45° field of view
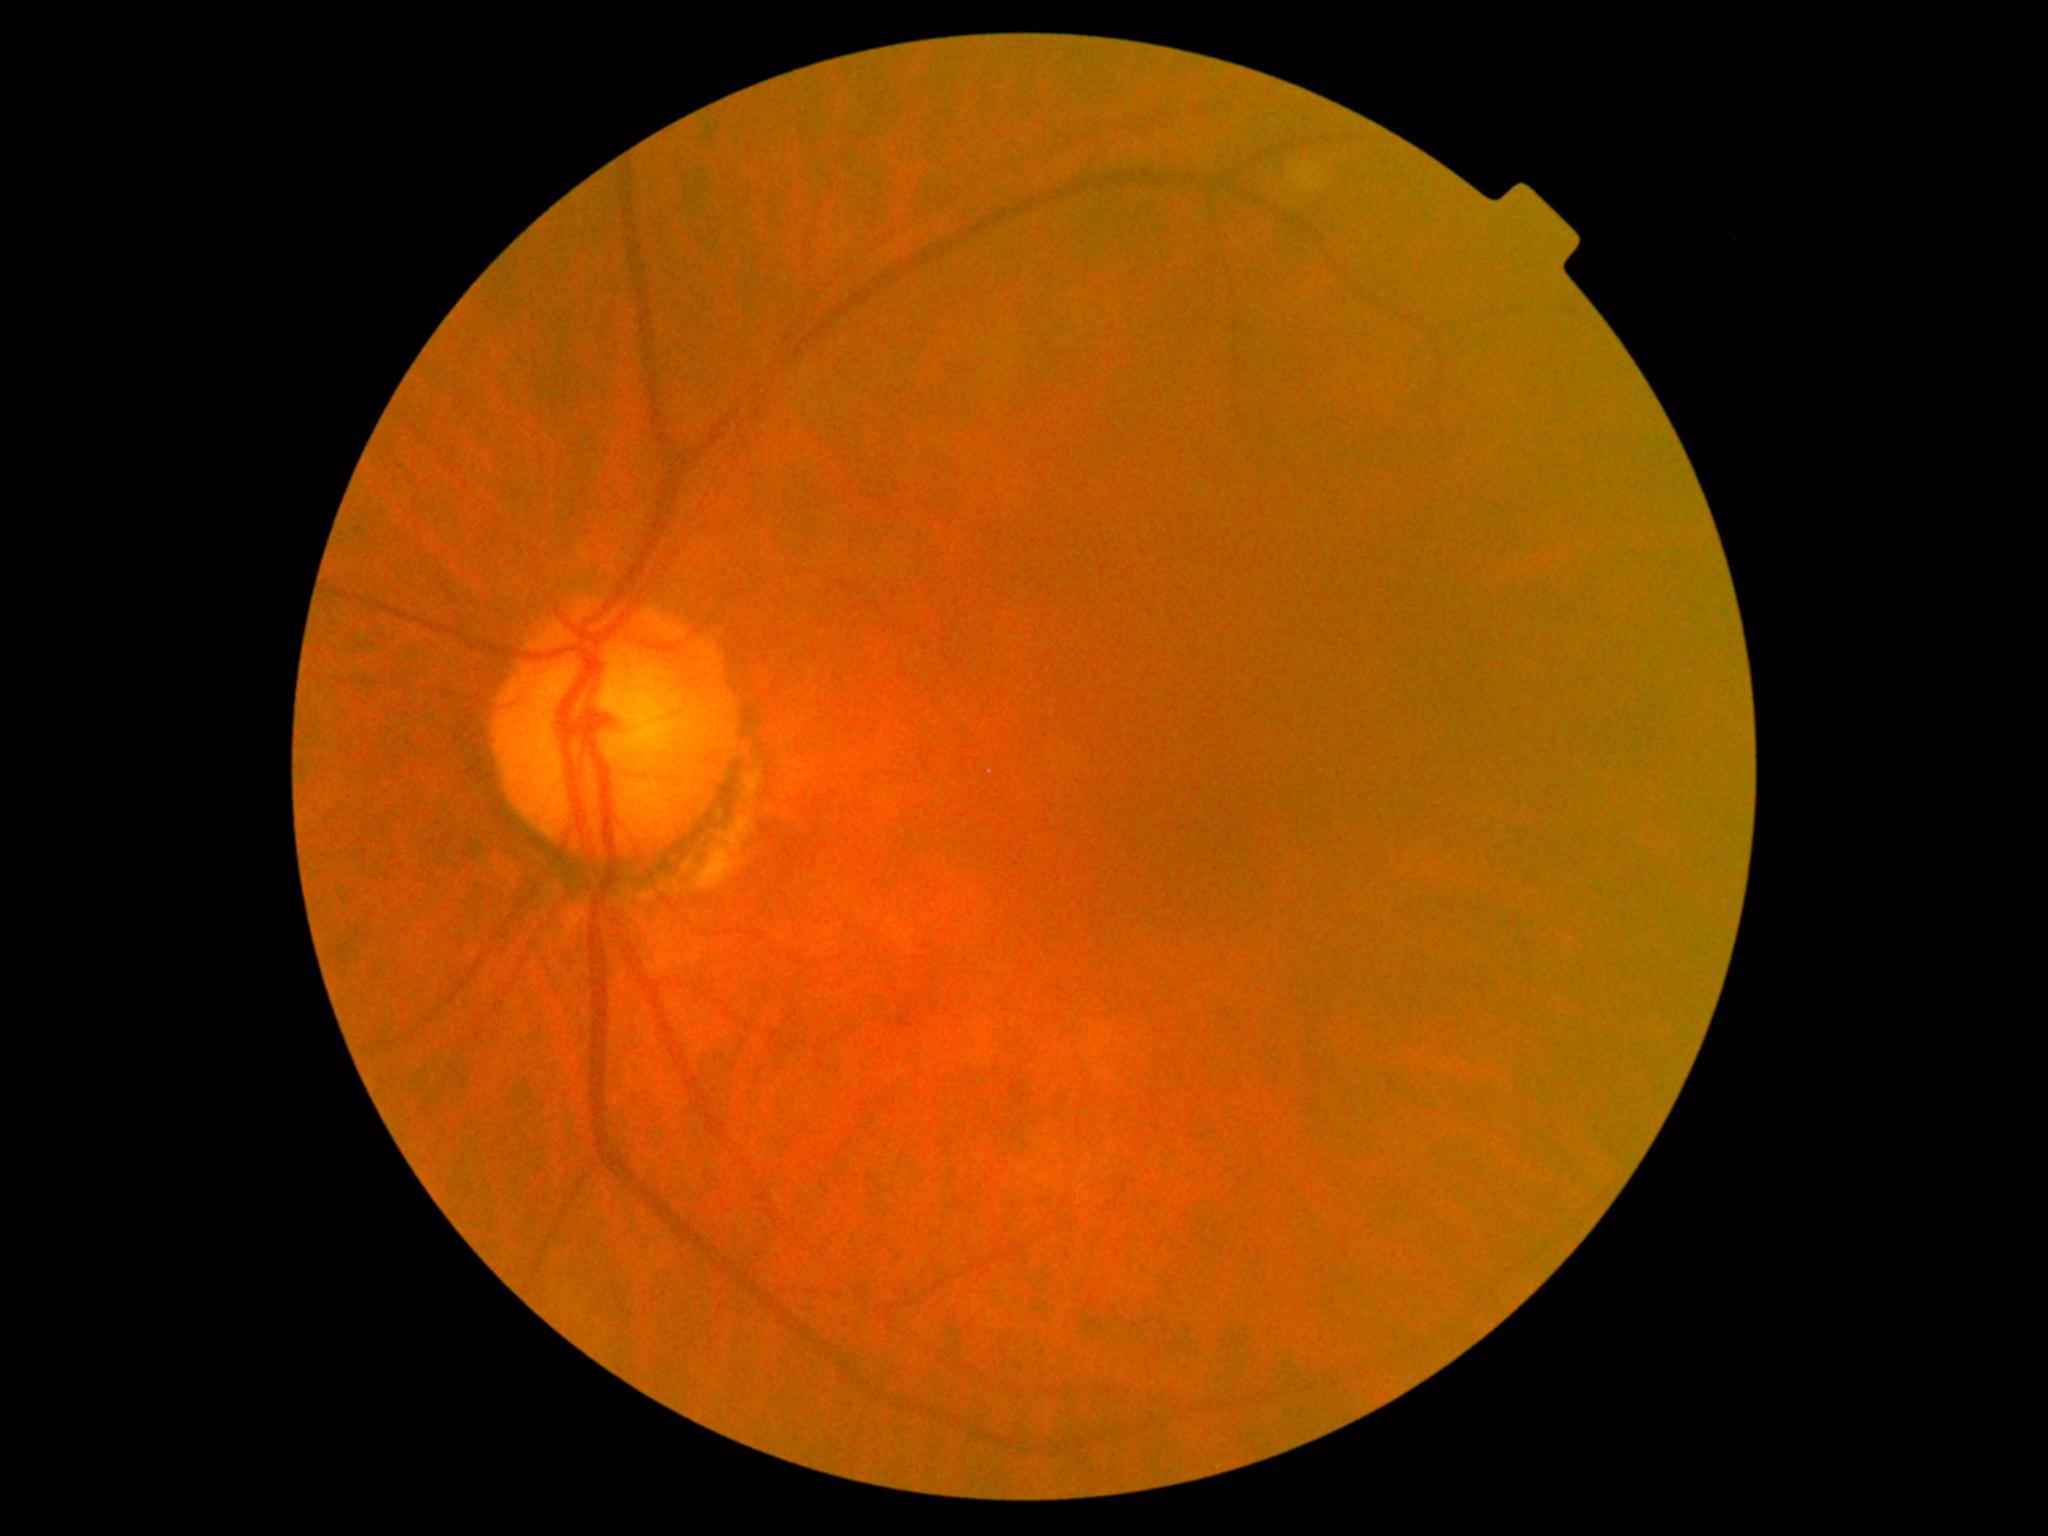

- DR grade: 0 (no apparent retinopathy) — no visible signs of diabetic retinopathy